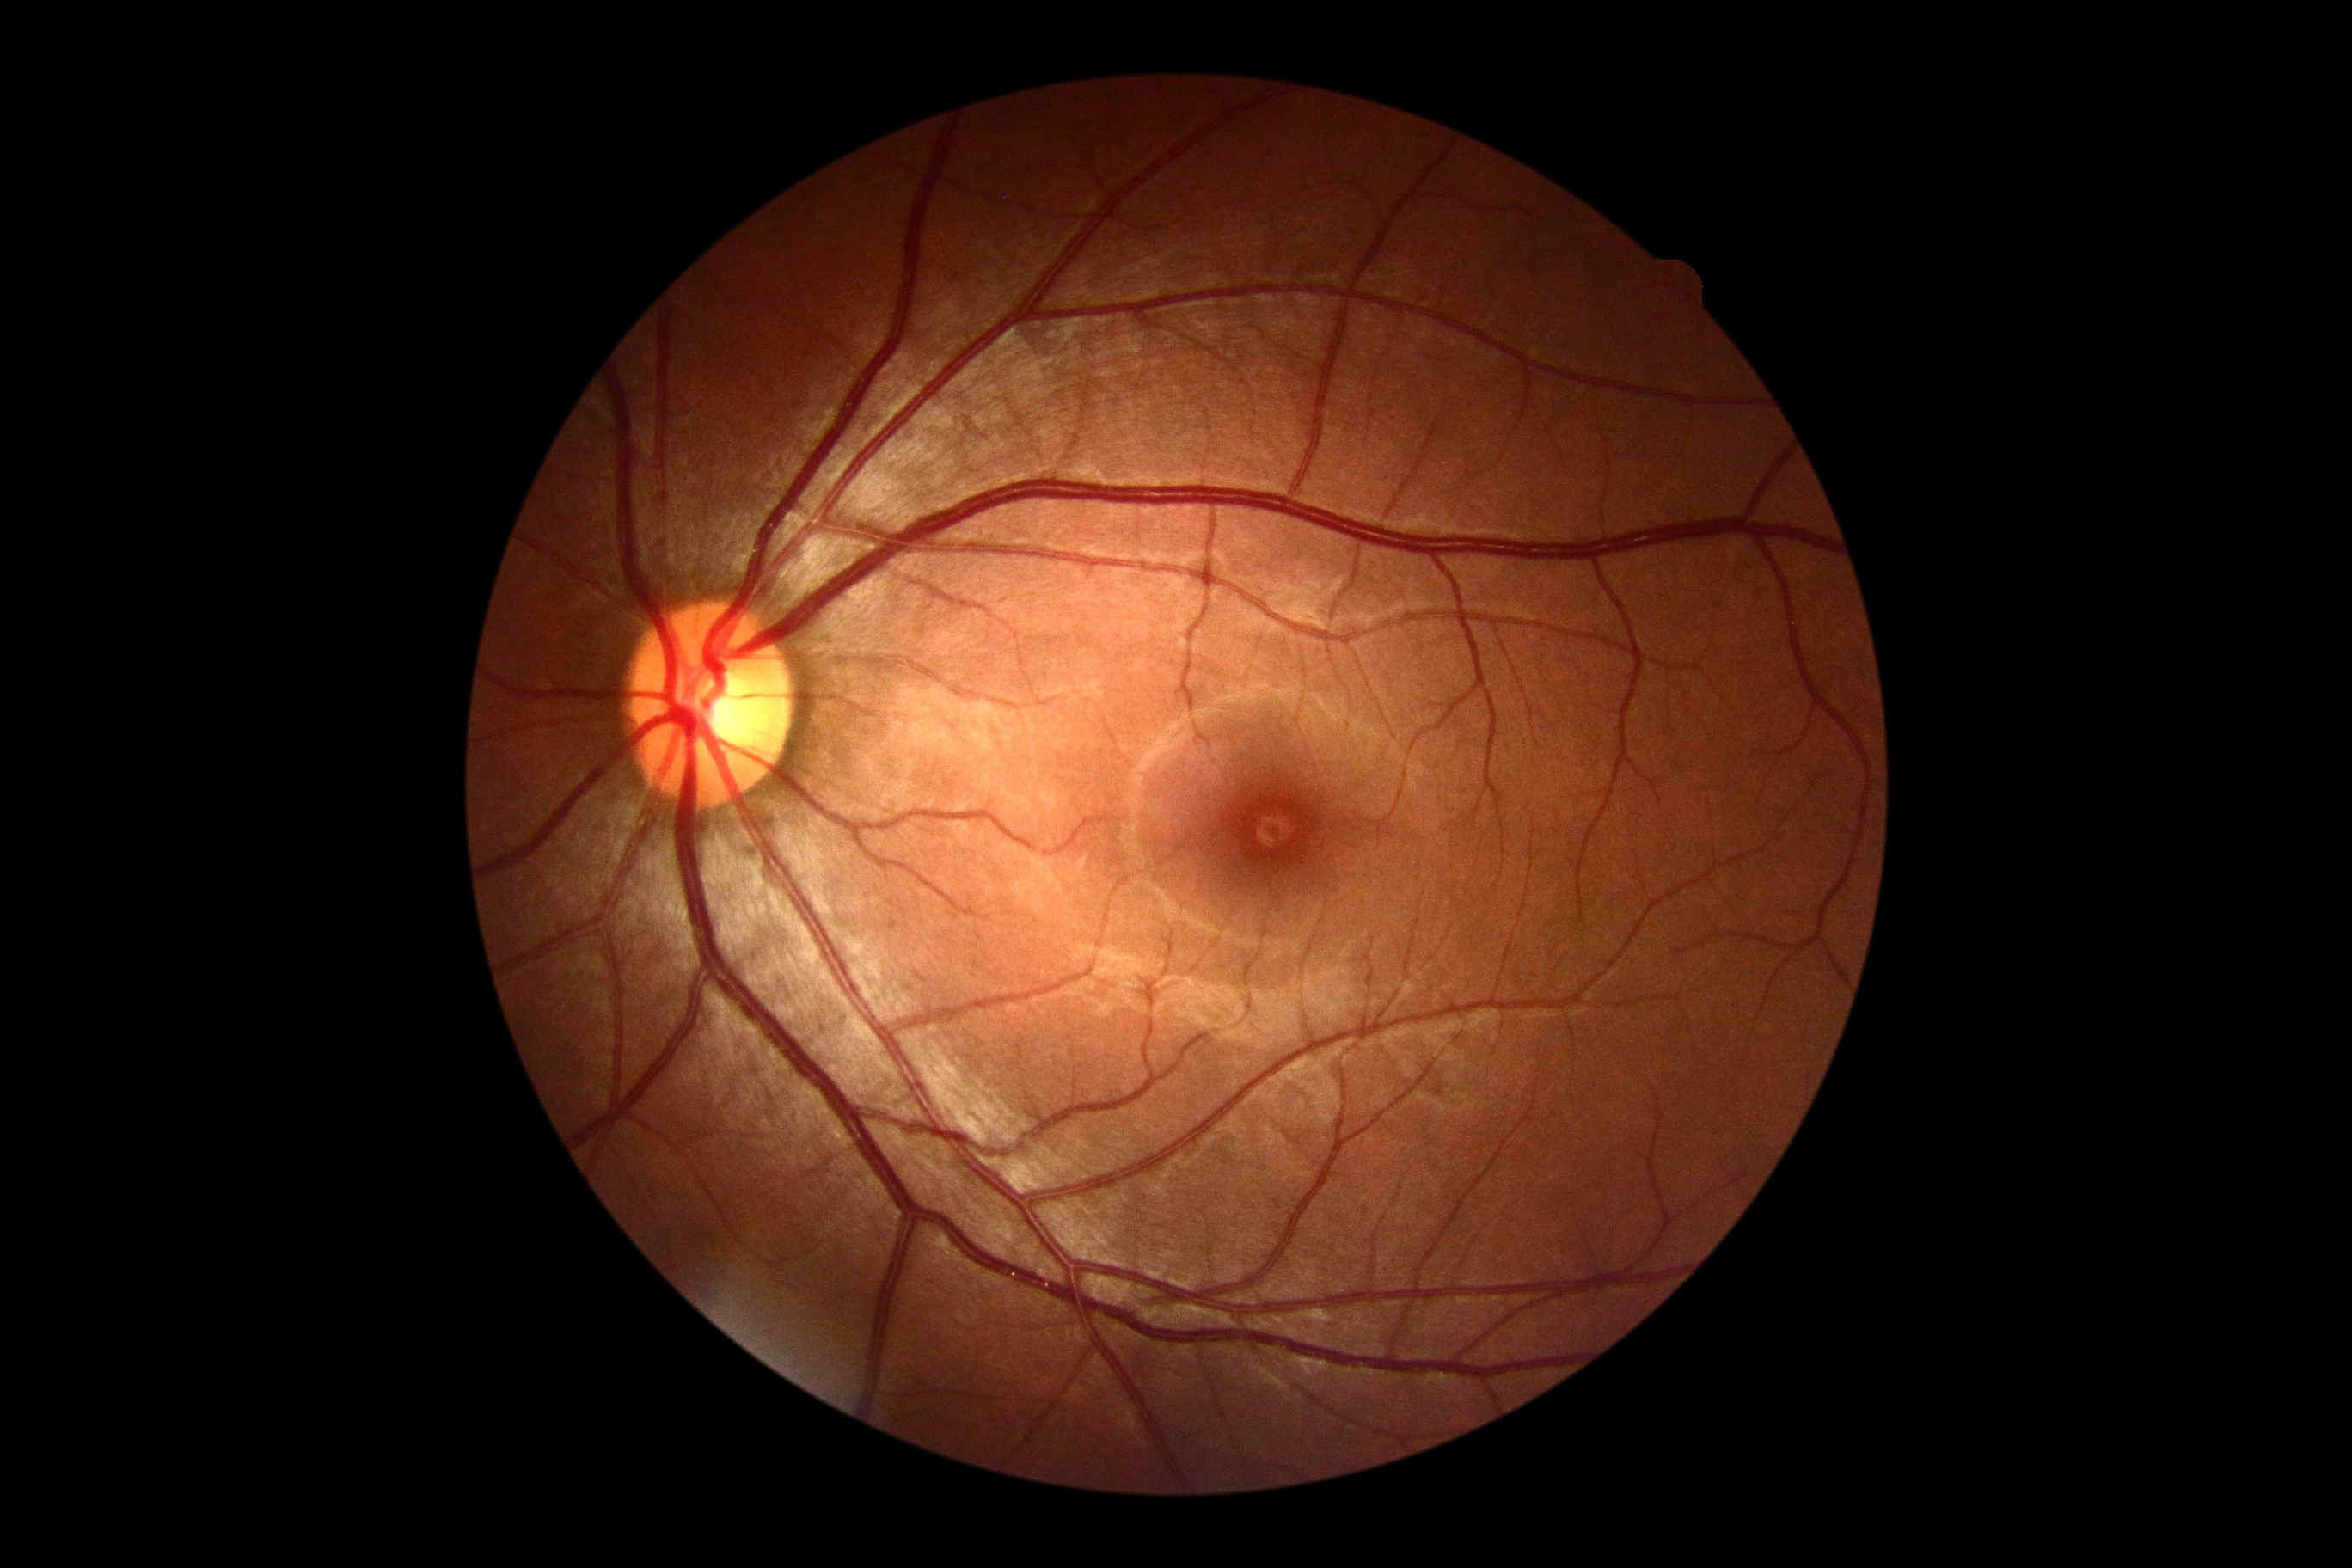 diabetic retinopathy: no apparent retinopathy (grade 0) — no visible signs of diabetic retinopathy | DR impression: no DR findings.